Posterior pole color fundus photograph · diabetic retinopathy graded by the modified Davis classification · NIDEK AFC-230 fundus camera.
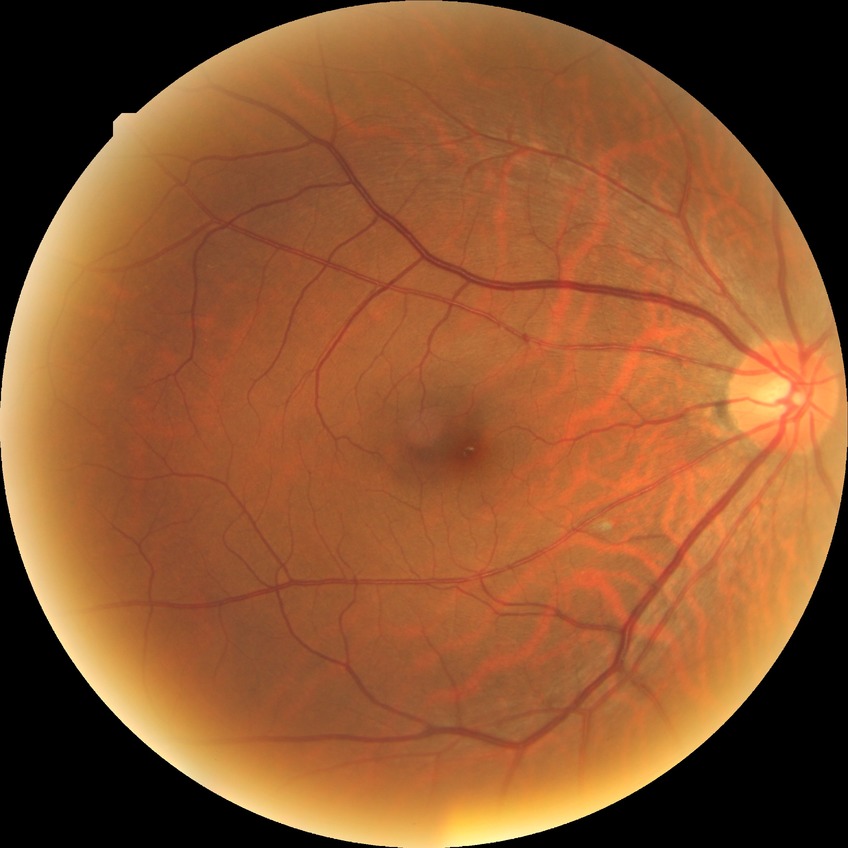
DR severity: NDR.